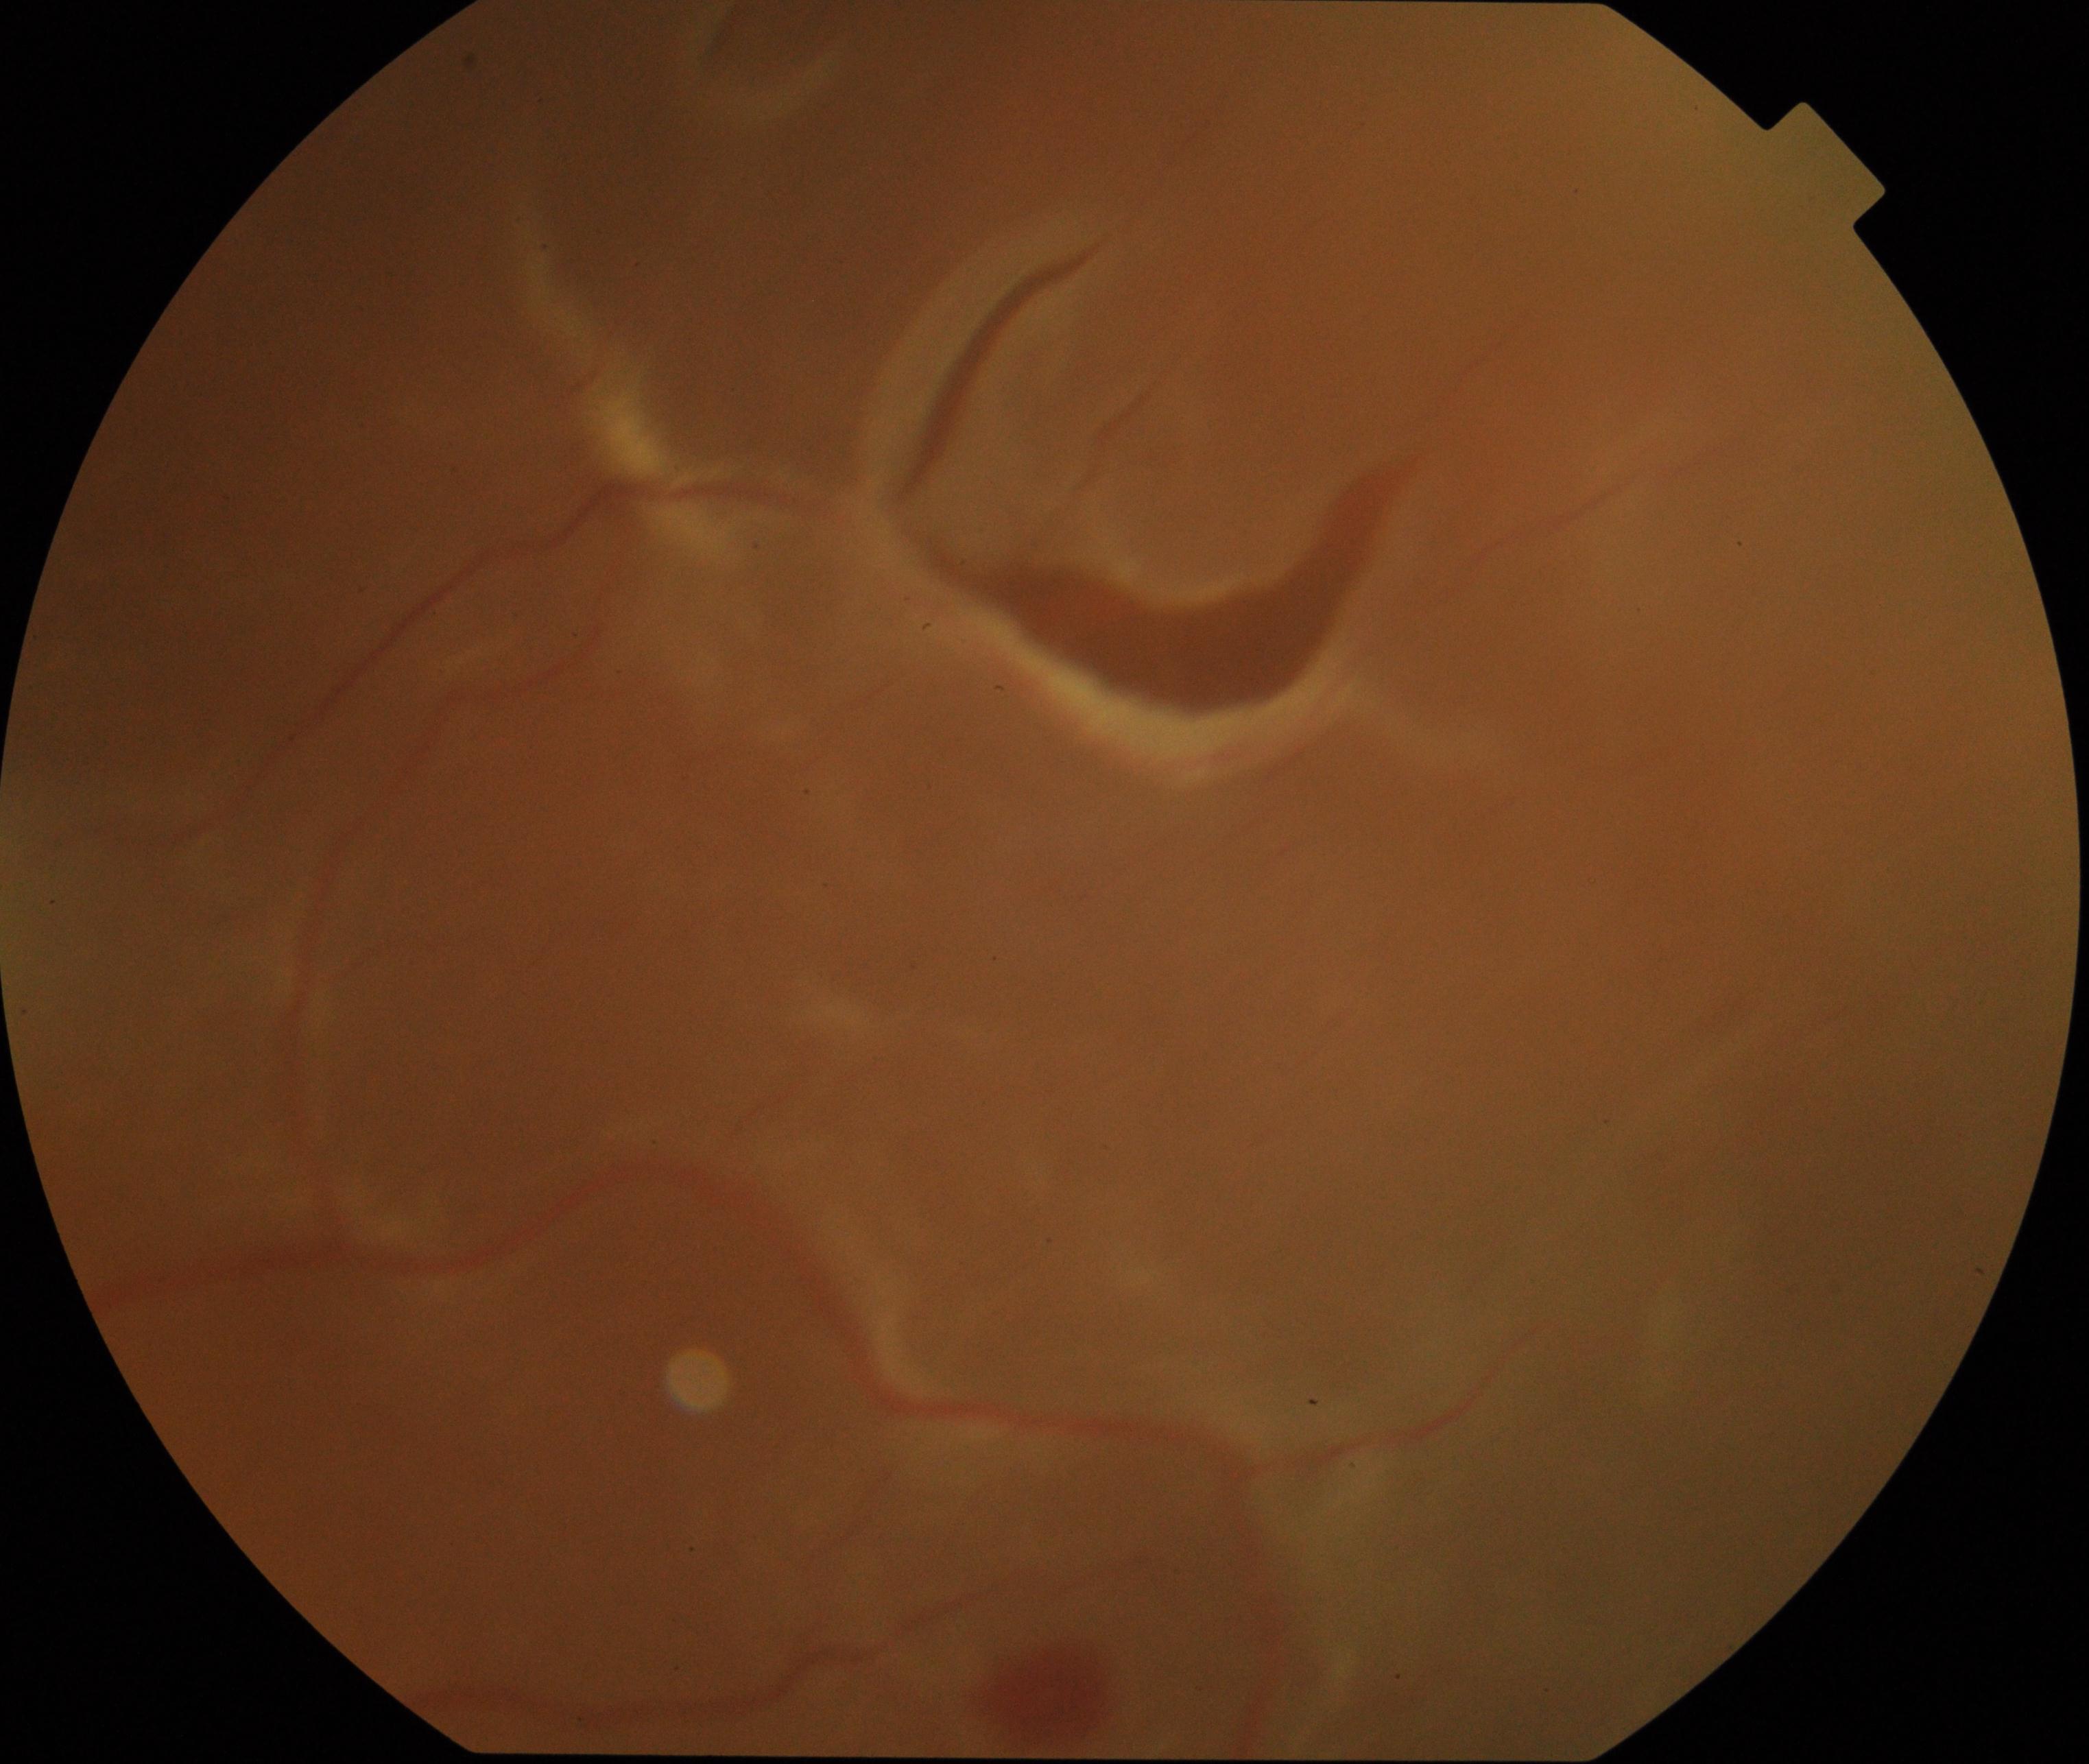
Classification: rhegmatogenous retinal detachment. Characterized by slightly opaque, convex or corrugated appearance of elevated retina, sometimes with retinal breaks in view.